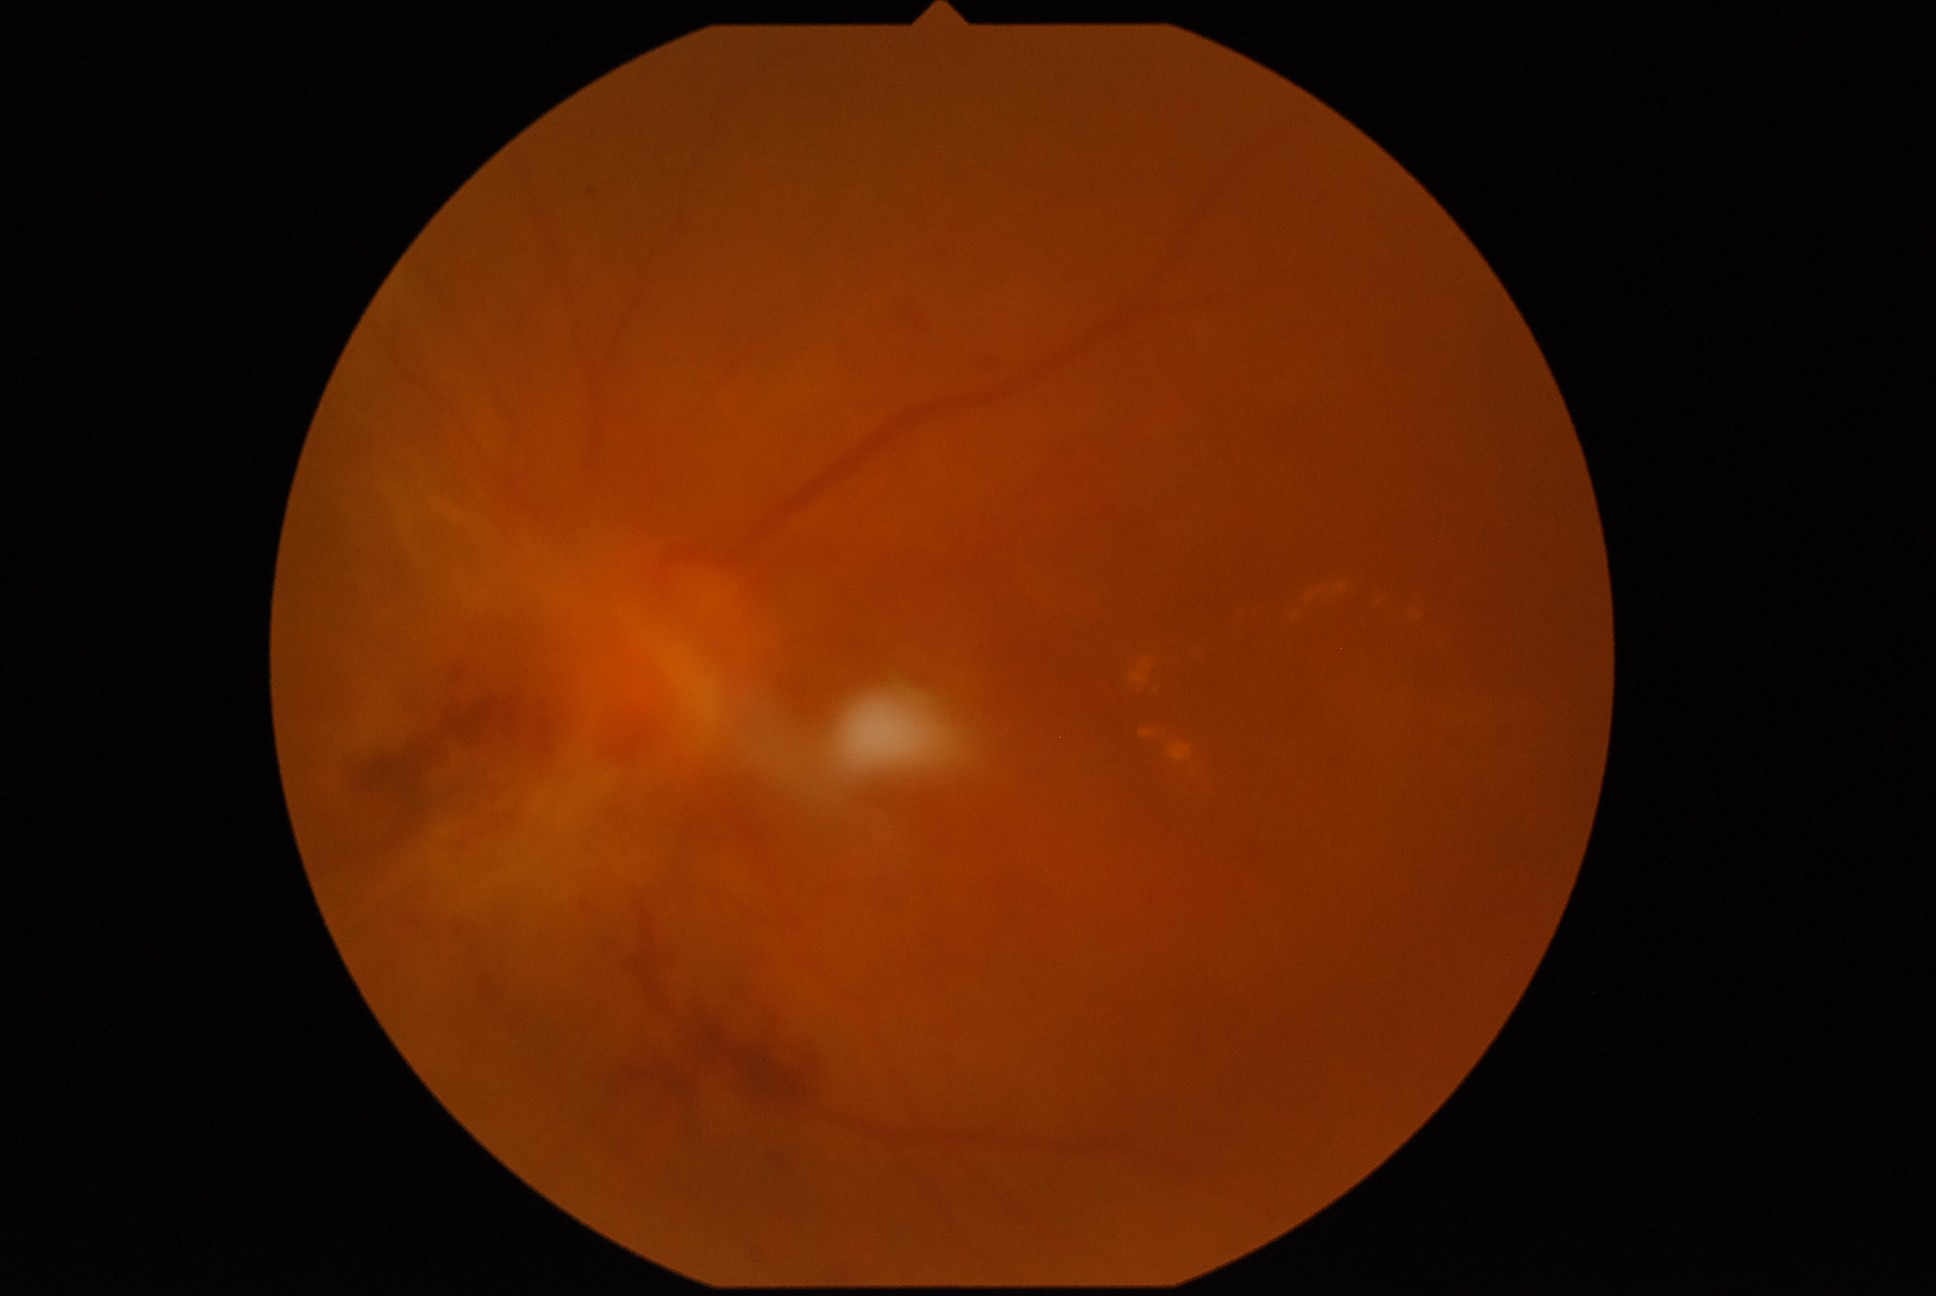
DR: PDR (grade 4).